Optic disc-centered crop from a color fundus photograph: 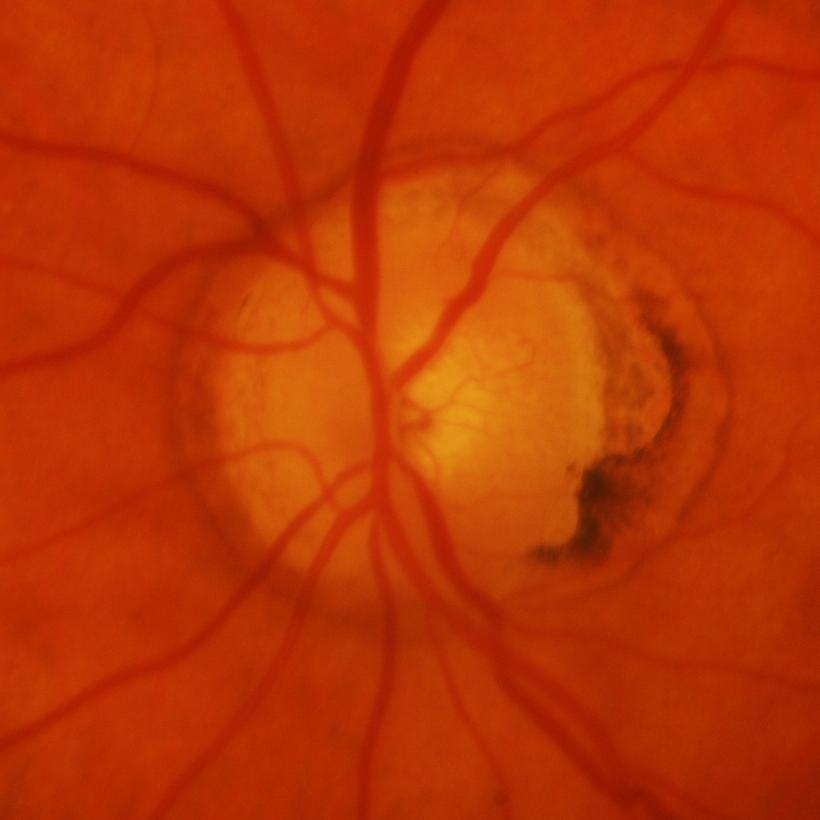 Glaucomatous findings.